Color fundus photograph: 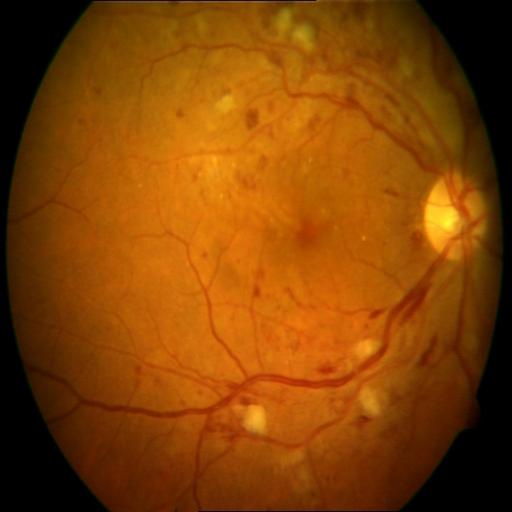

Abnormalities (3): cotton wool spots (CWS) | central retinal vein occlusion (CRVO) | hemorrhagic retinopathy (HR).